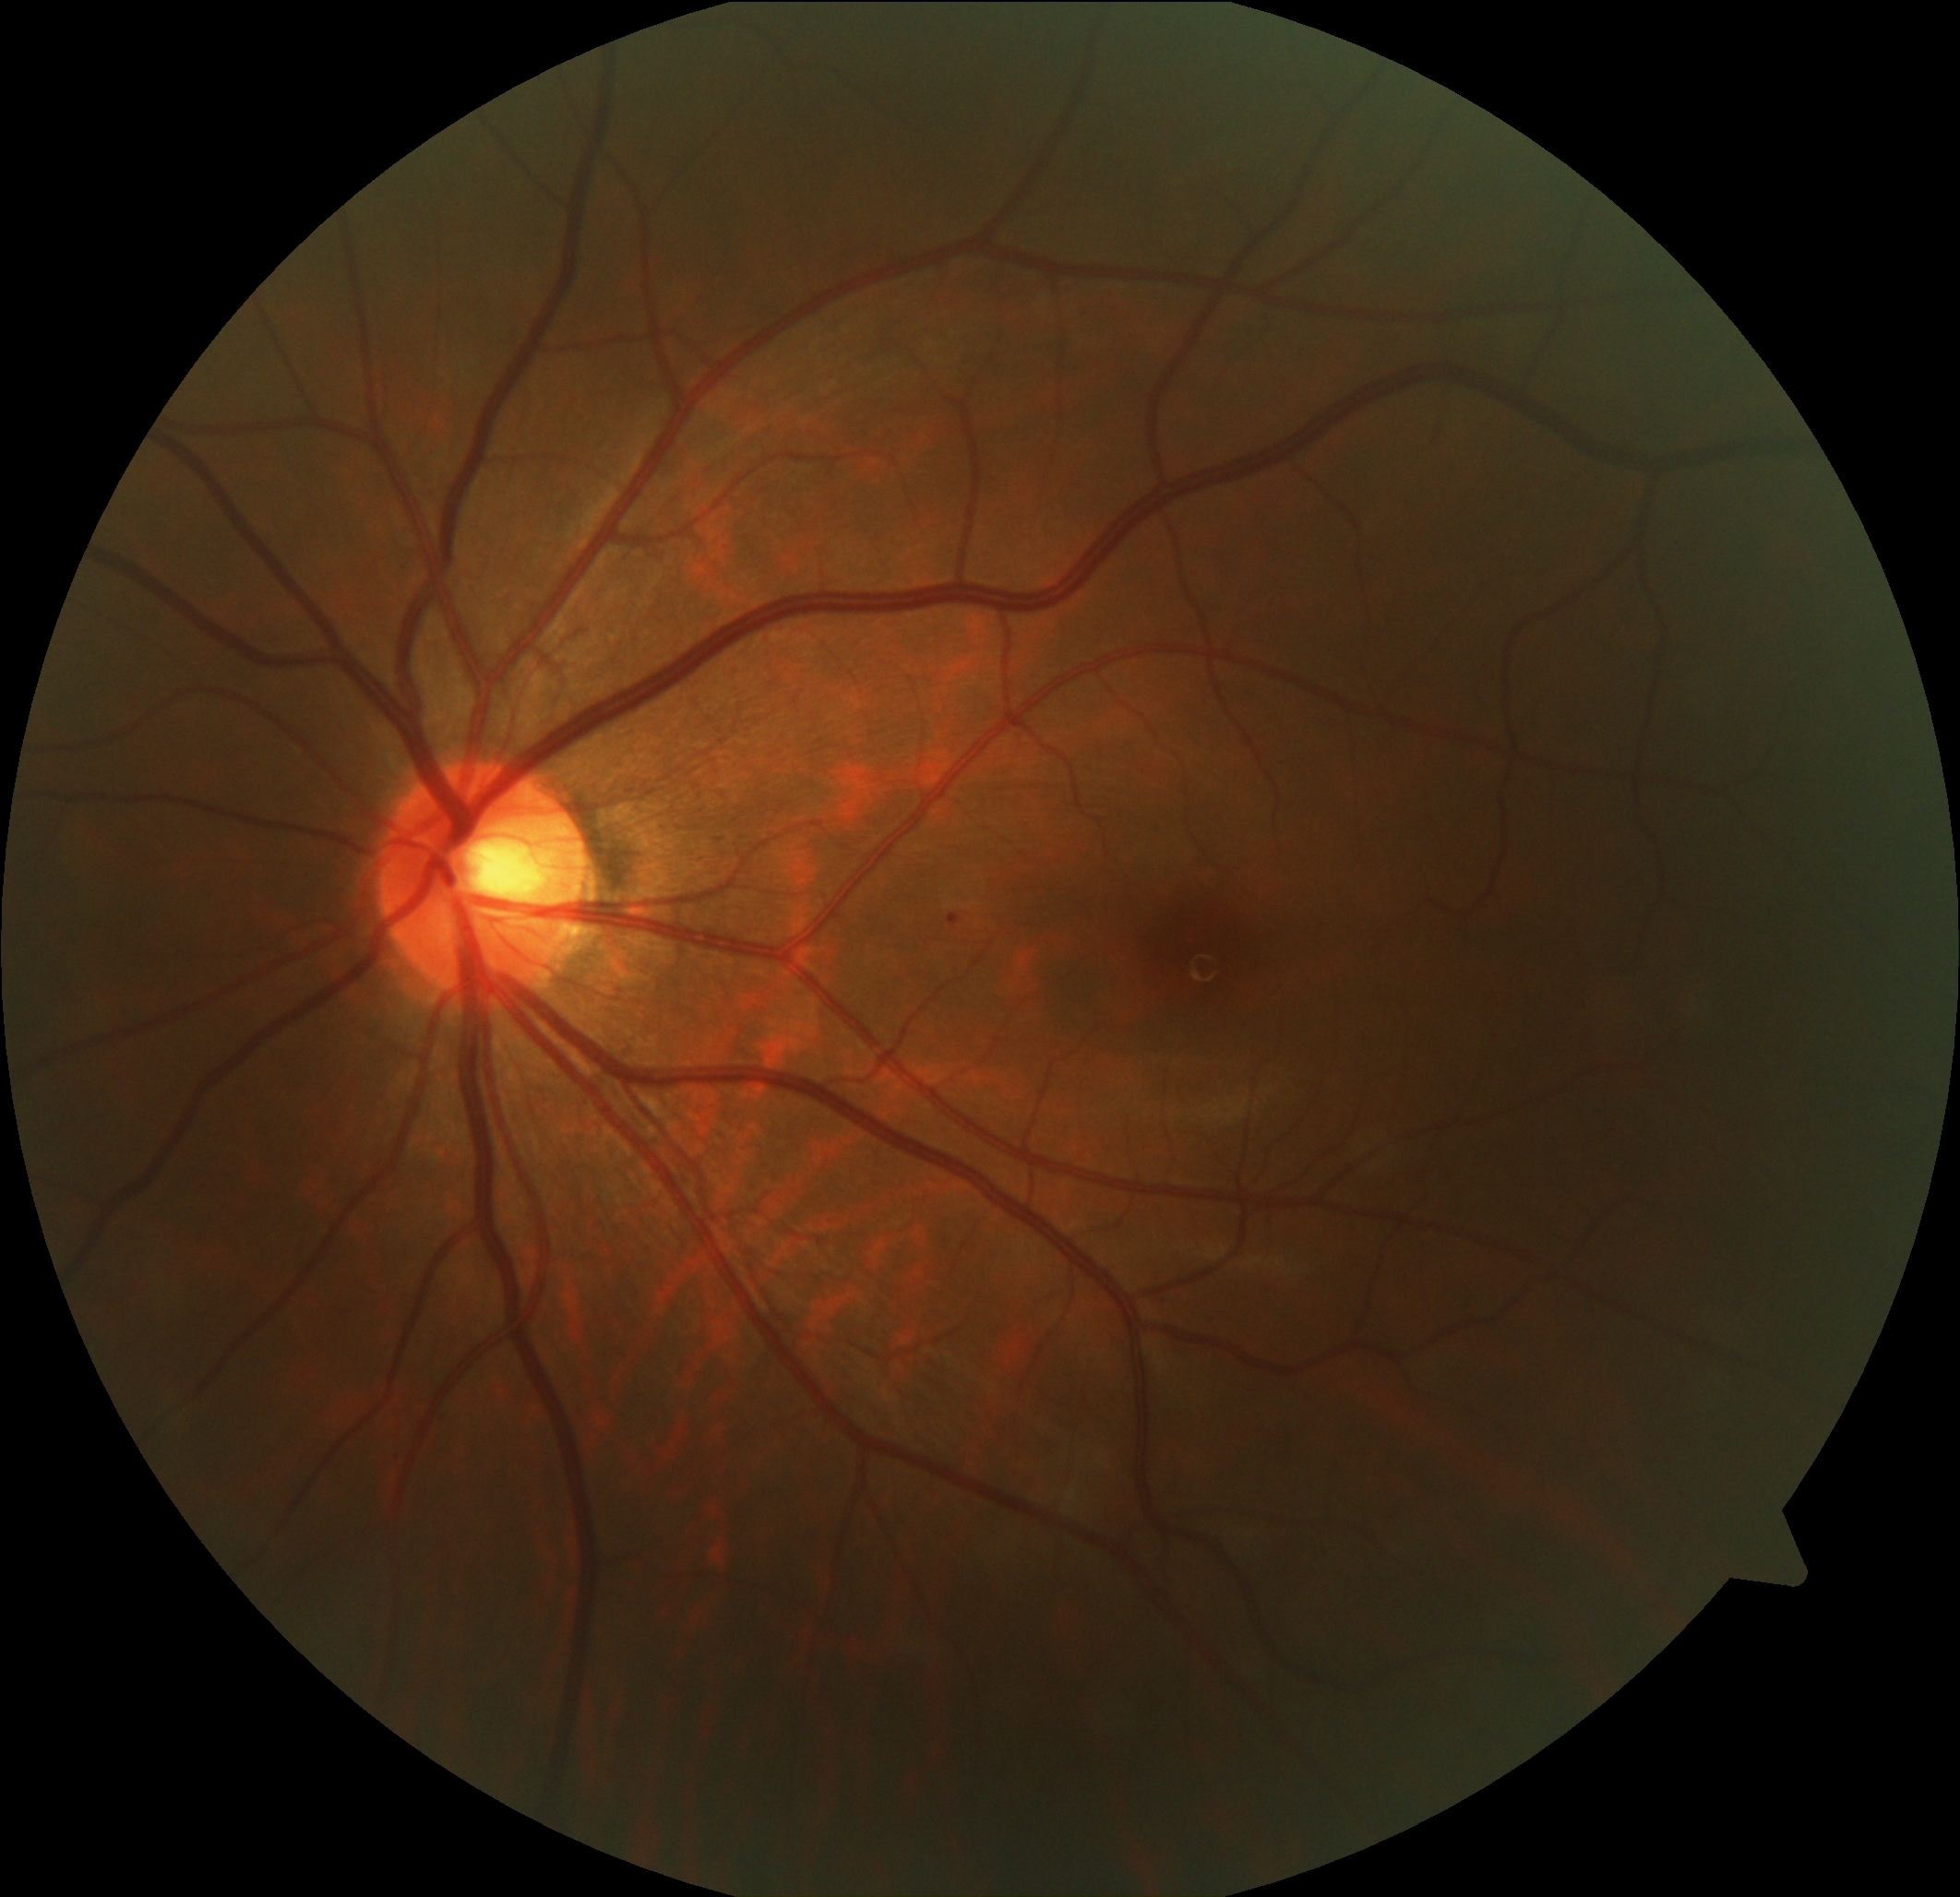

DR: grade 1 (mild NPDR).